Camera: Phoenix ICON (100° FOV). 1240 x 1240 pixels. Infant wide-field retinal image.
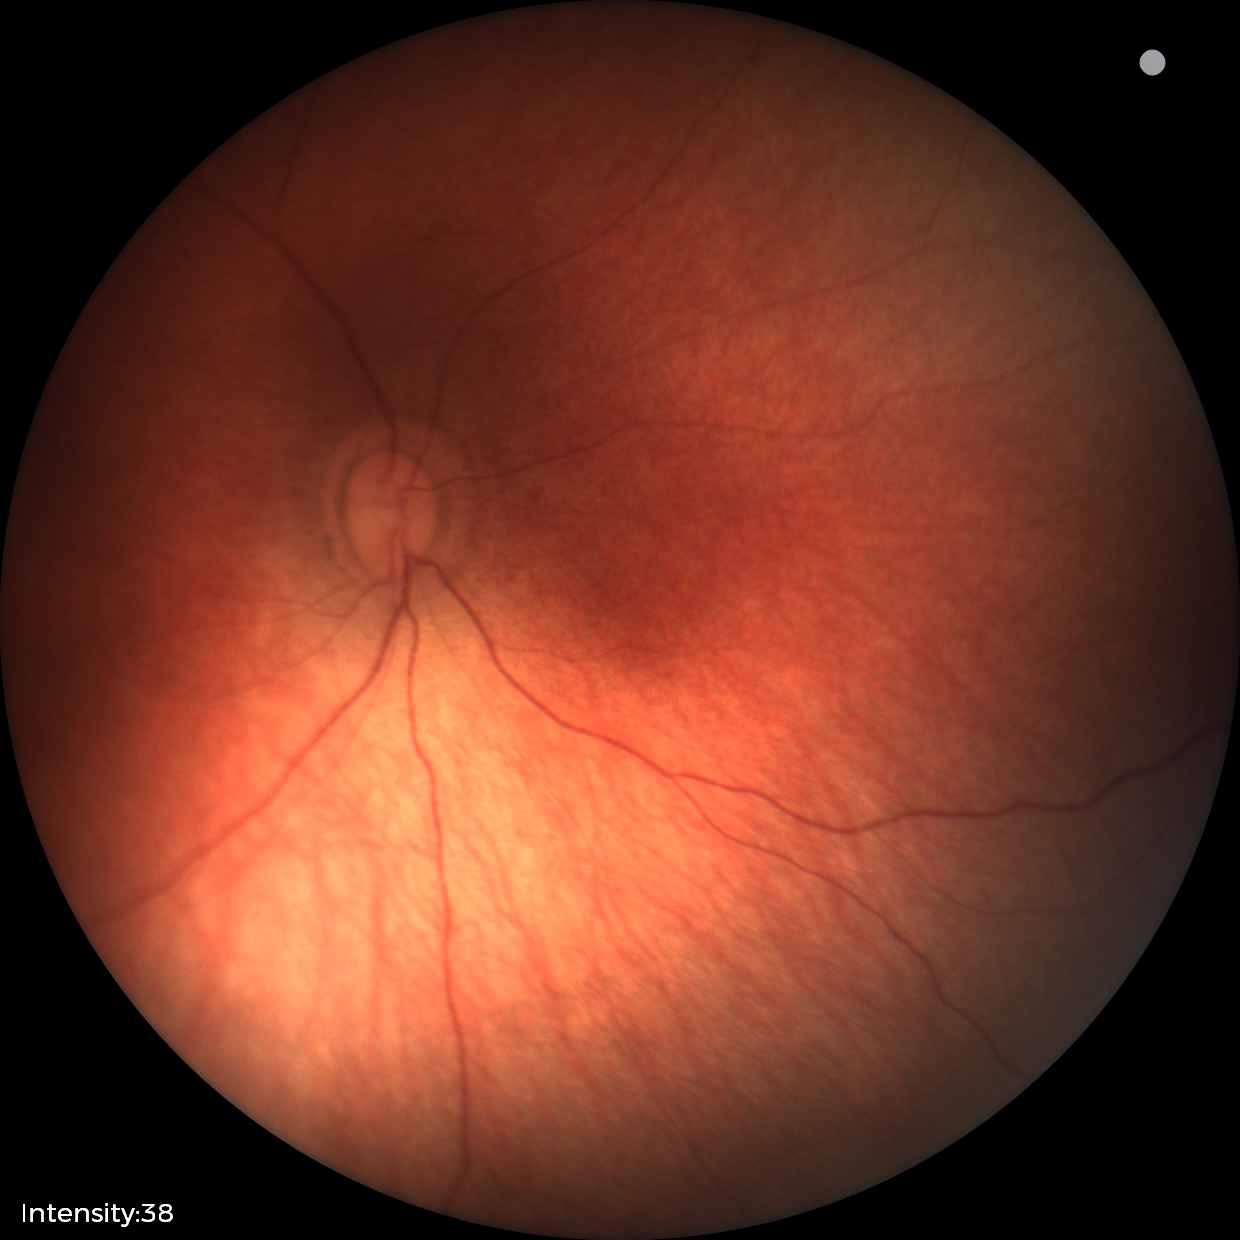

Screening examination diagnosed as physiological.